Retinal fundus photograph.
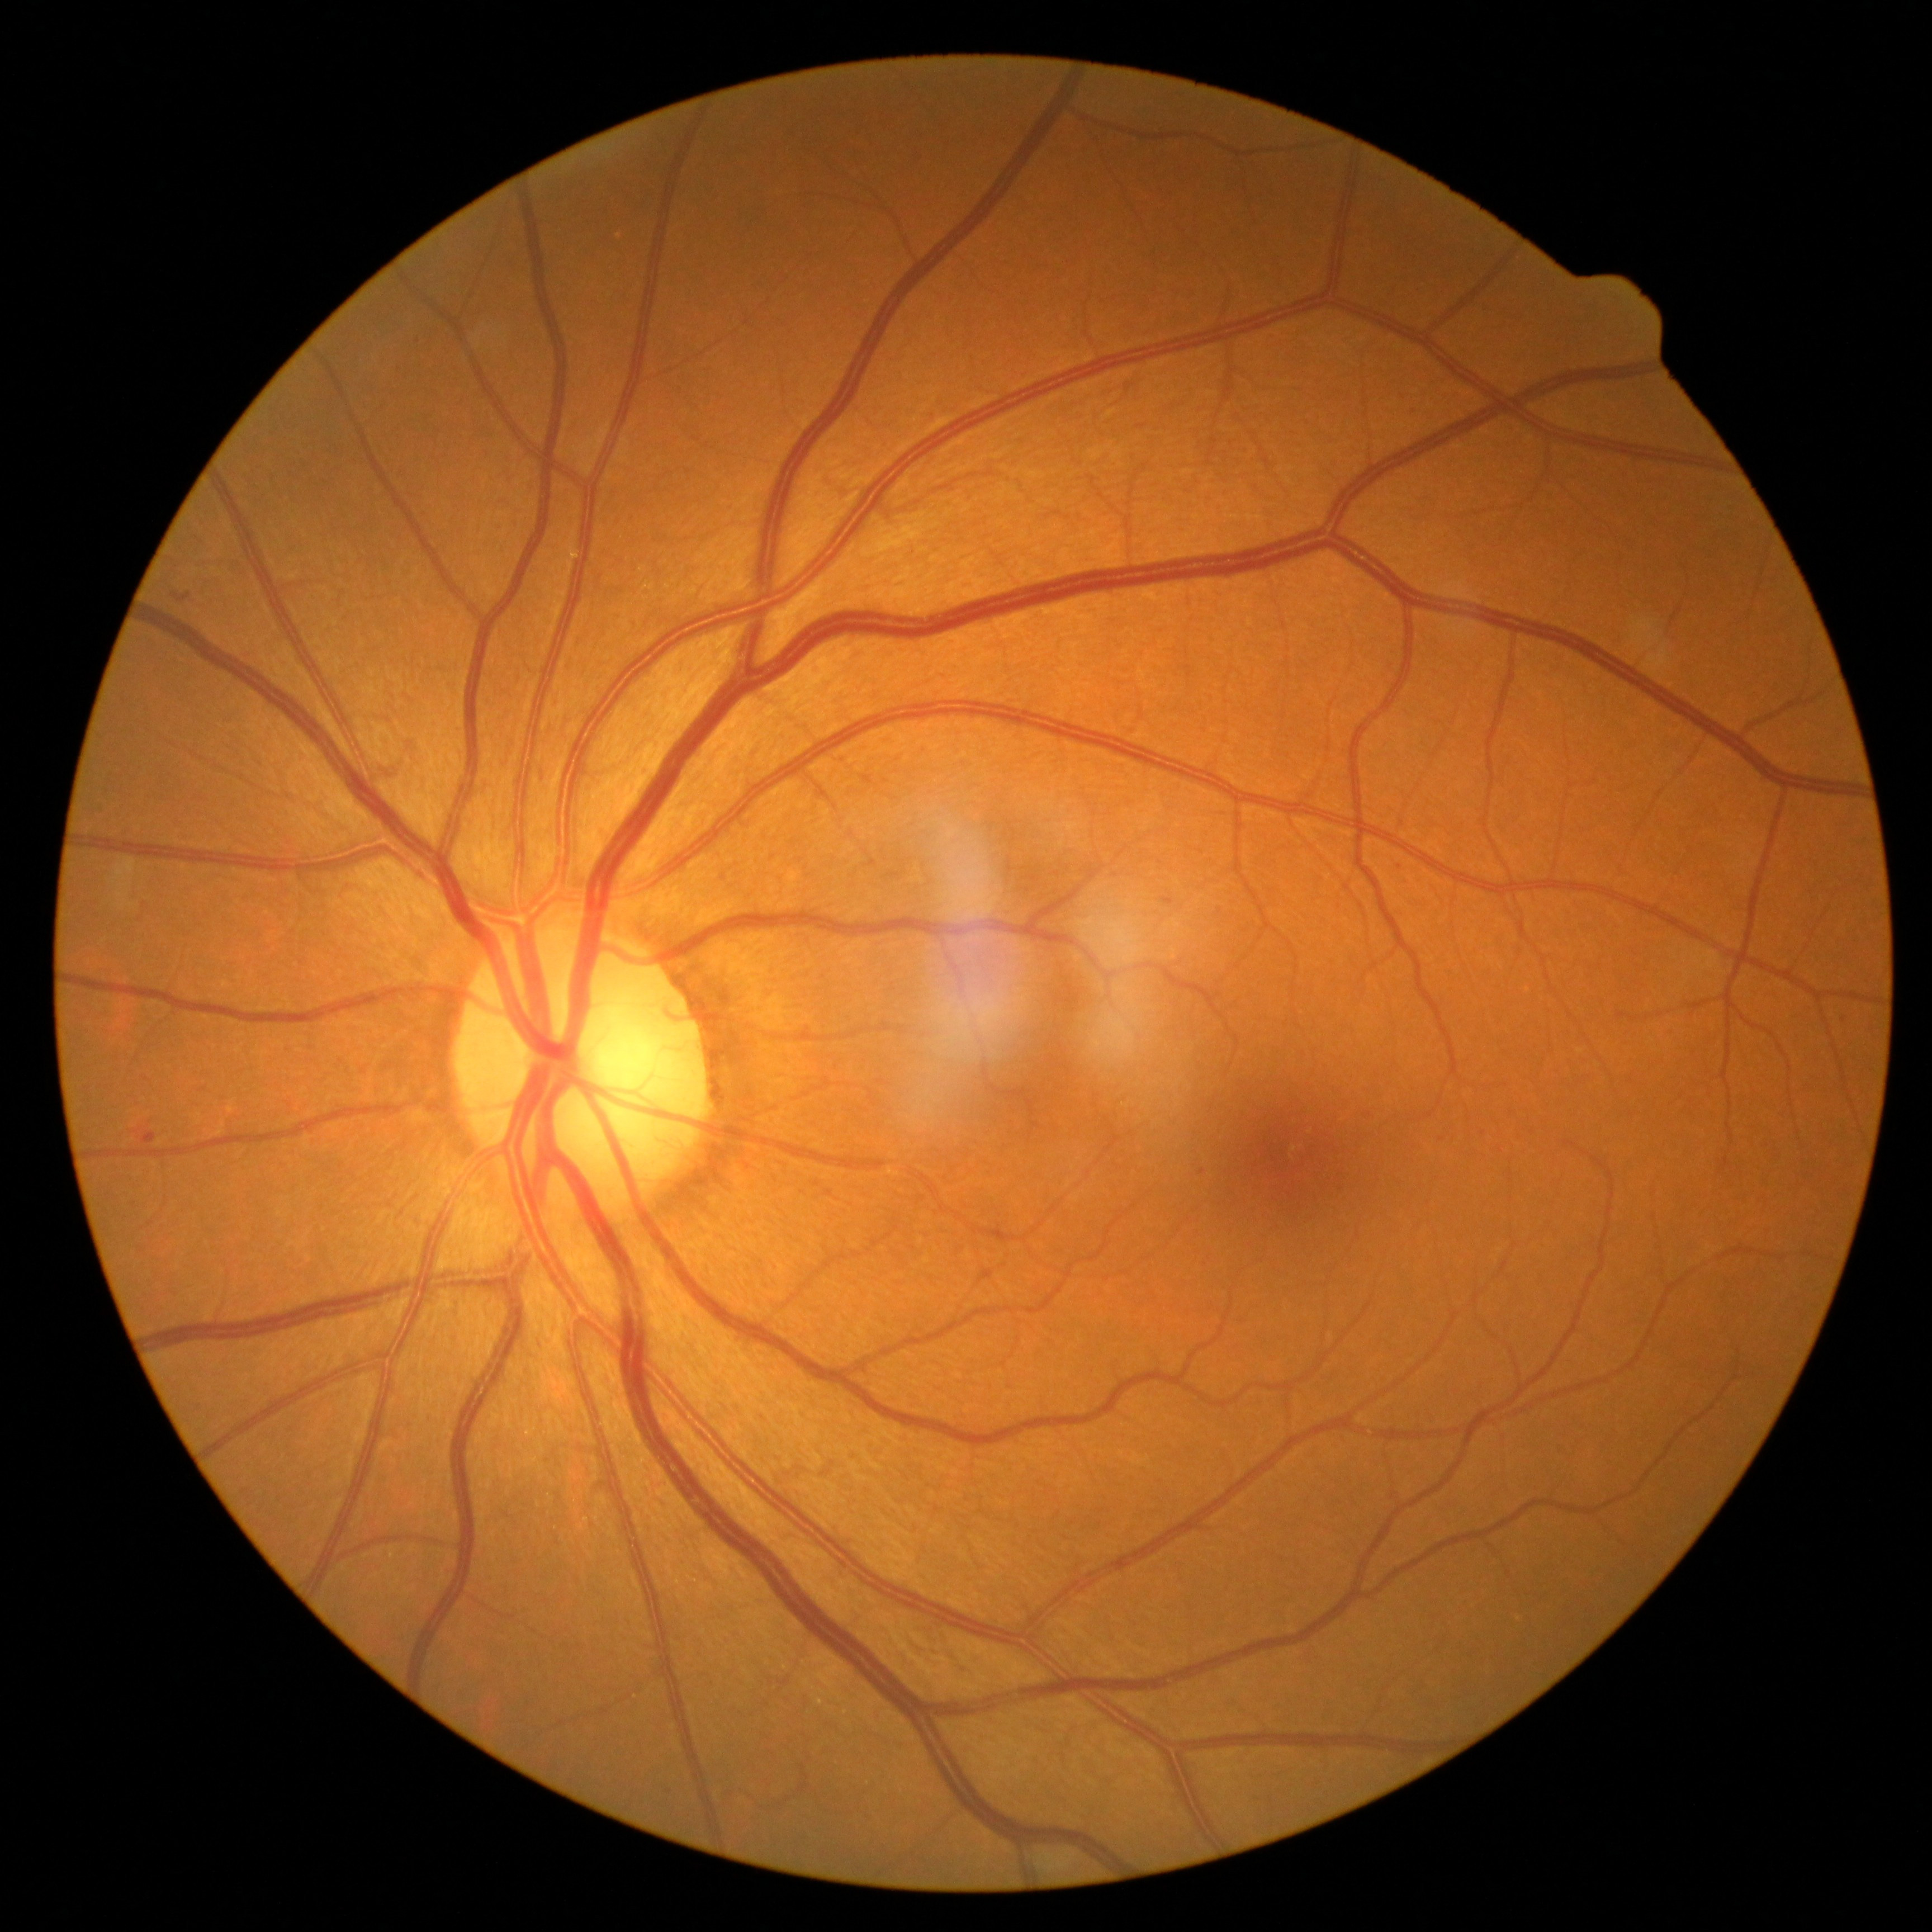 {"dr_grade": "mild non-proliferative diabetic retinopathy (1)"}